45° FOV. Fundus photo. Image size 2048x1536.
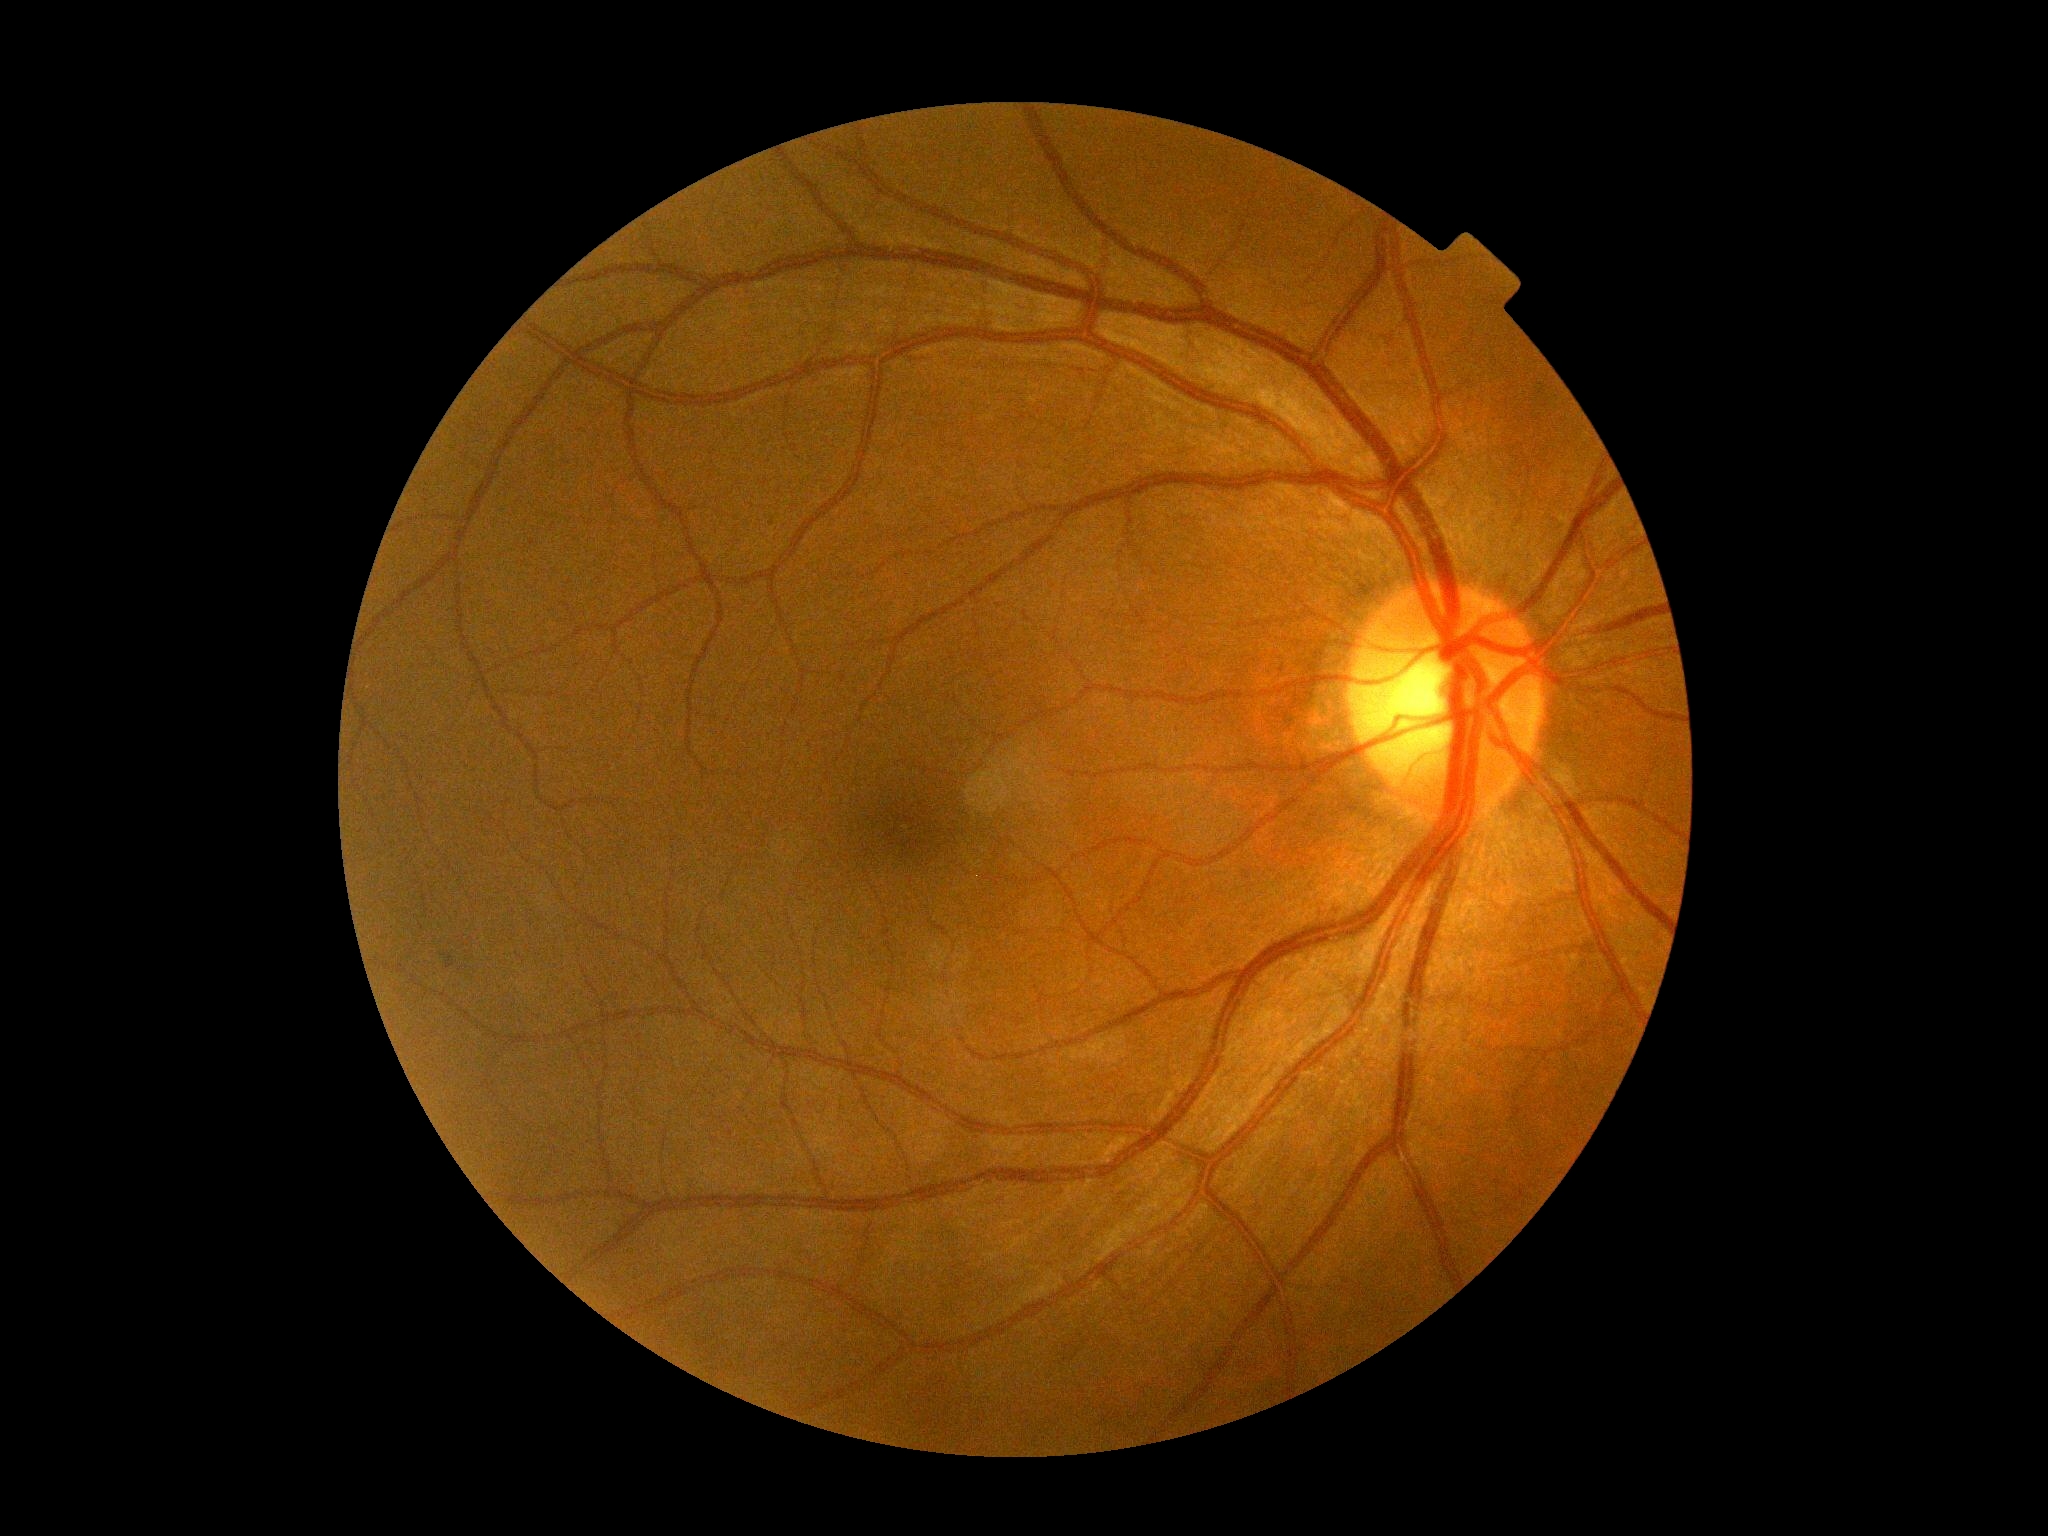

dr_impression: no apparent DR
dr_grade: 0/4 — no visible signs of diabetic retinopathy